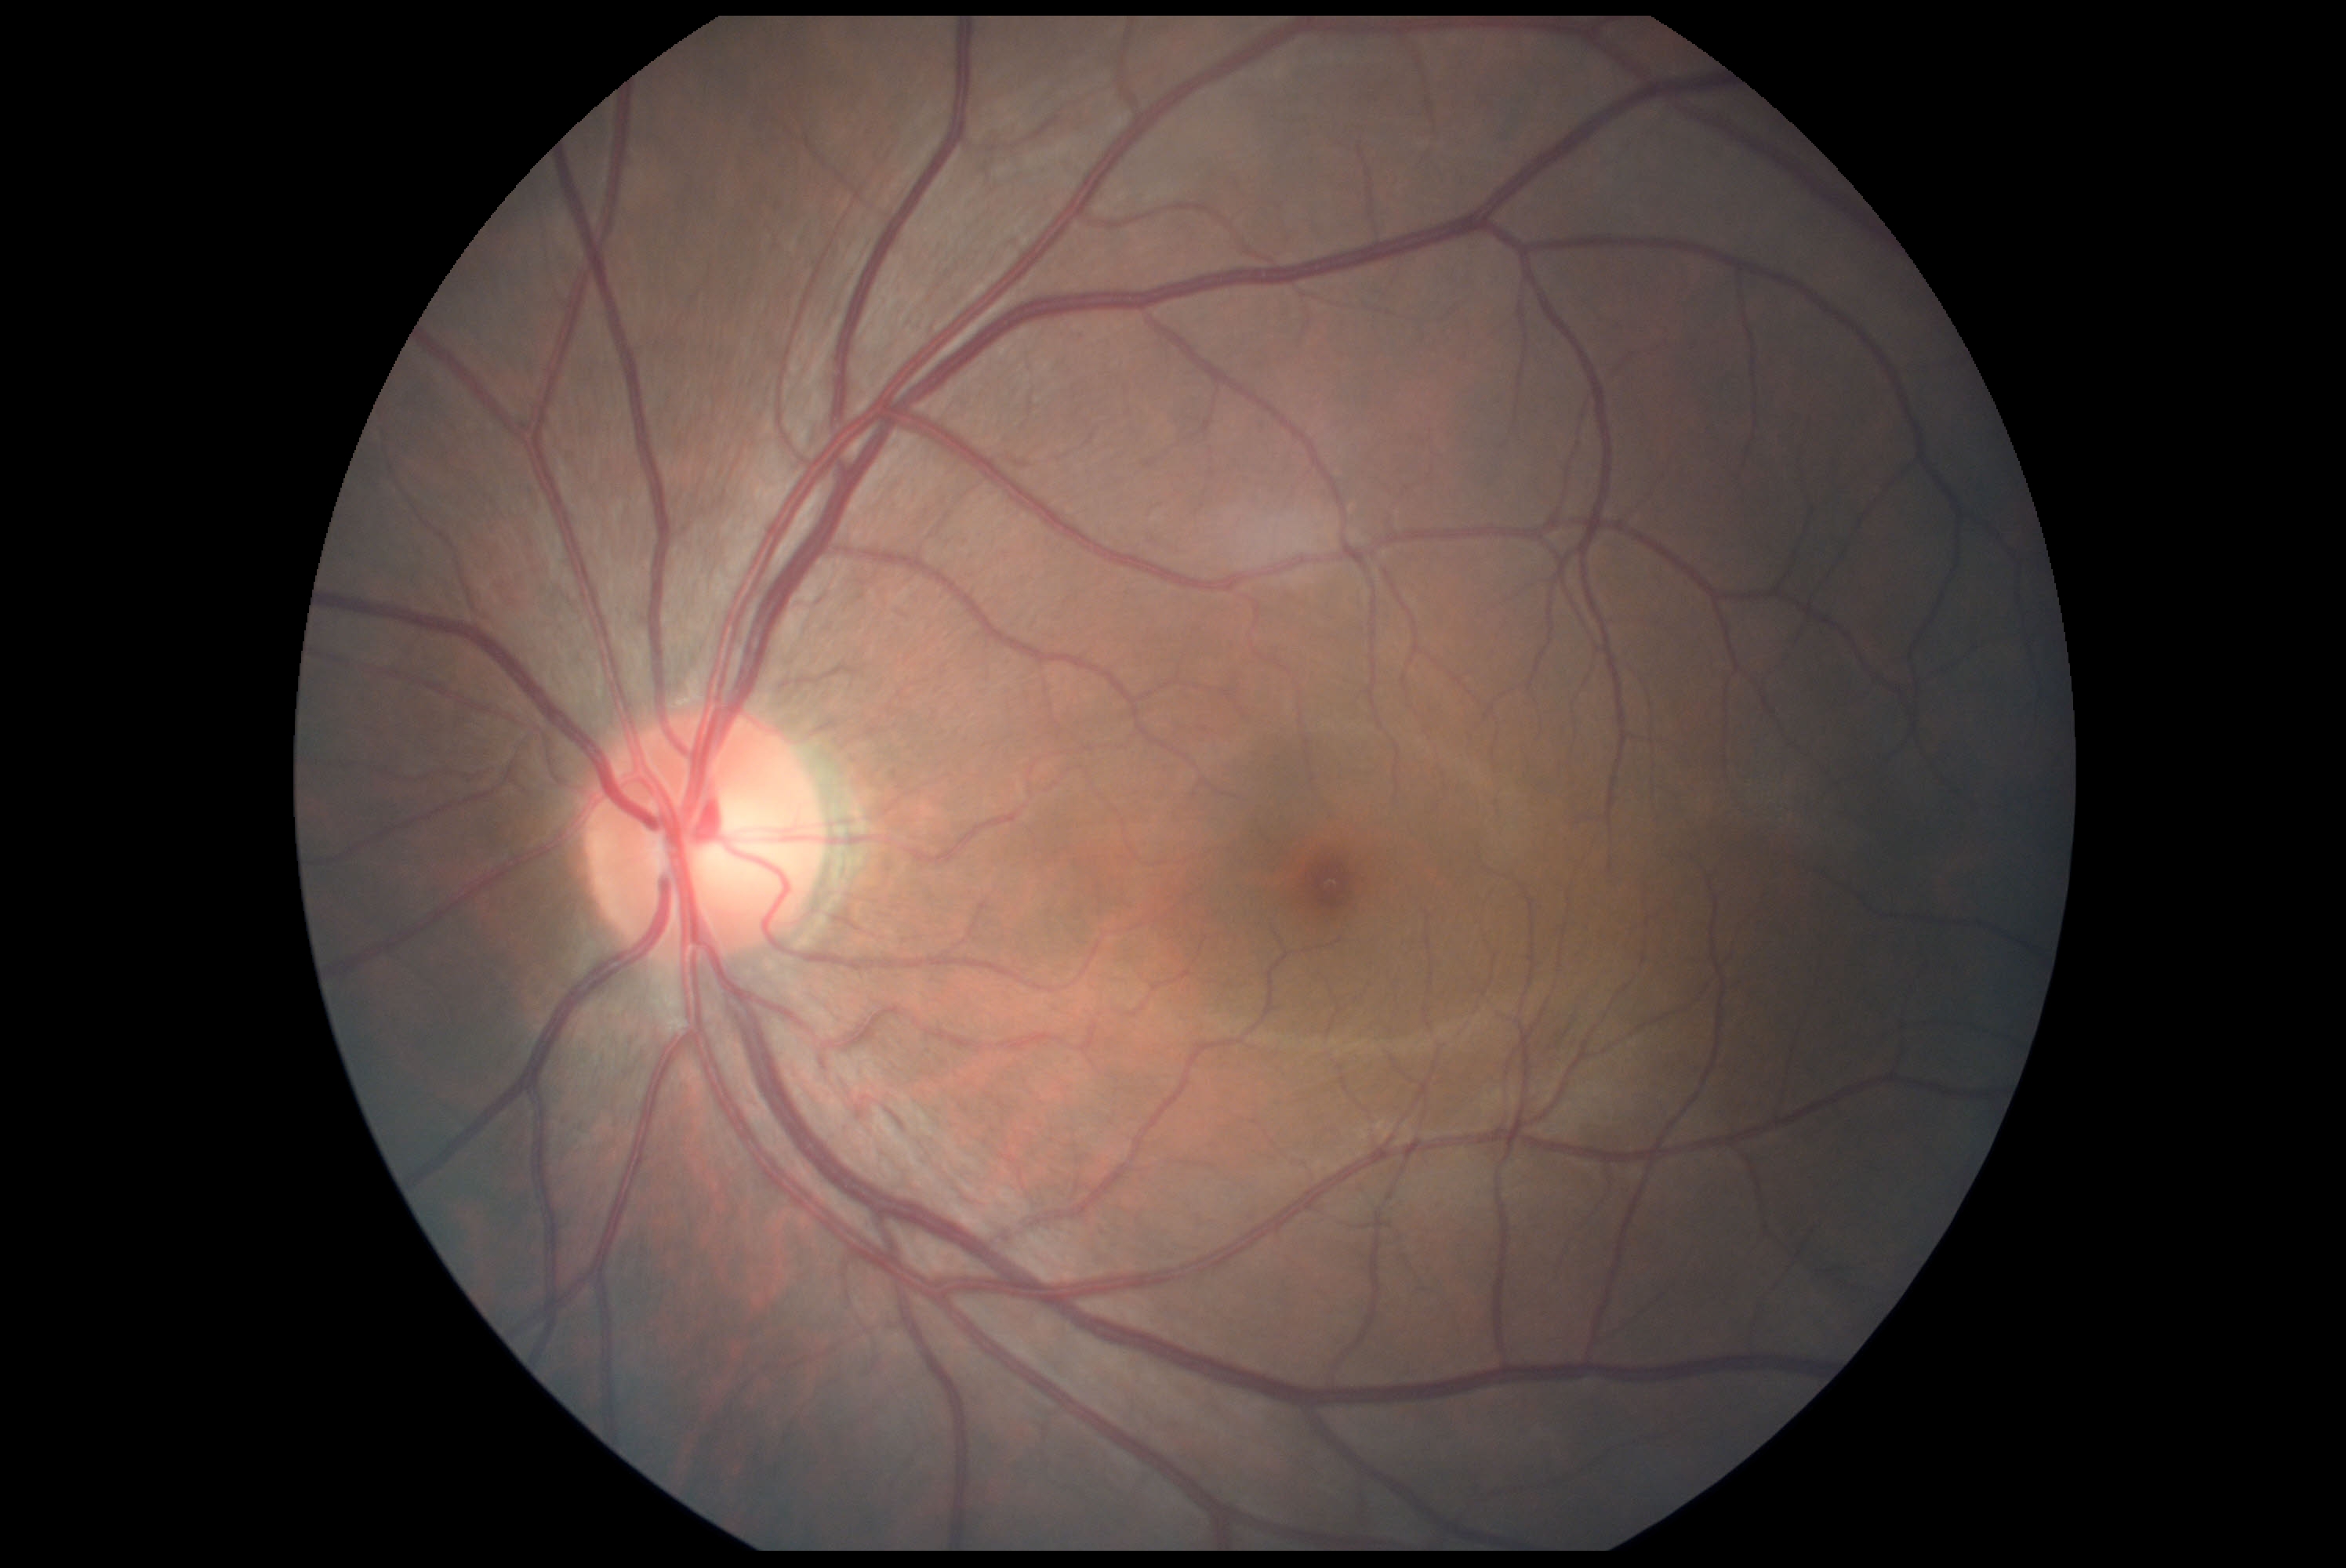

  dr_impression: no DR findings
  dr_grade: 0 — no visible signs of diabetic retinopathy